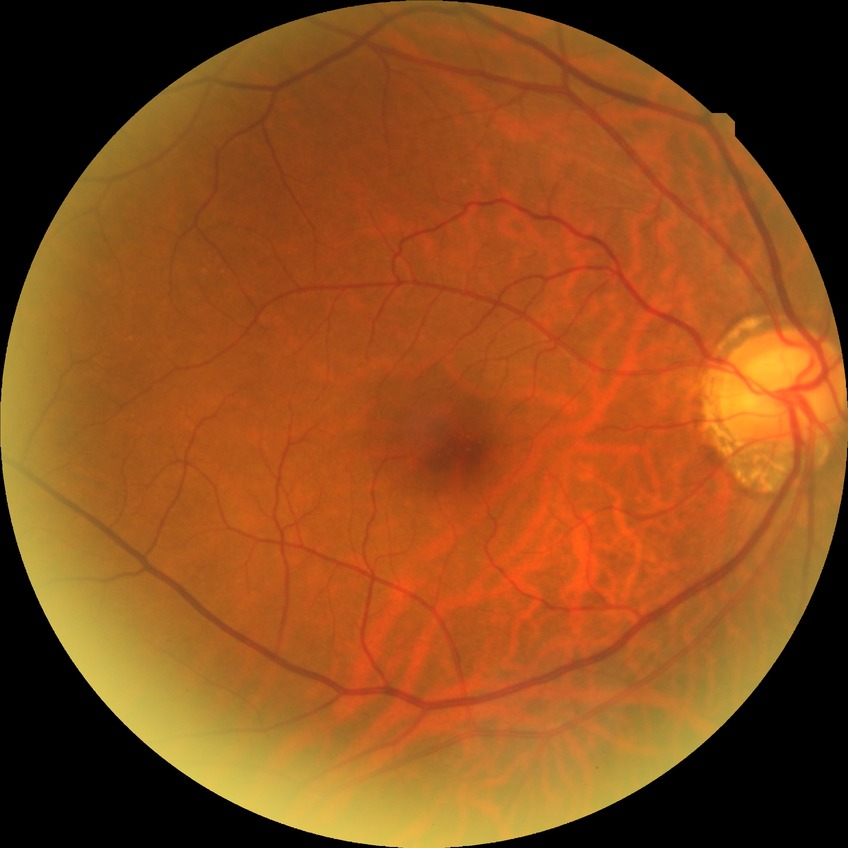
DR stage=NDR.